Camera: NIDEK AFC-230; diabetic retinopathy graded by the modified Davis classification: 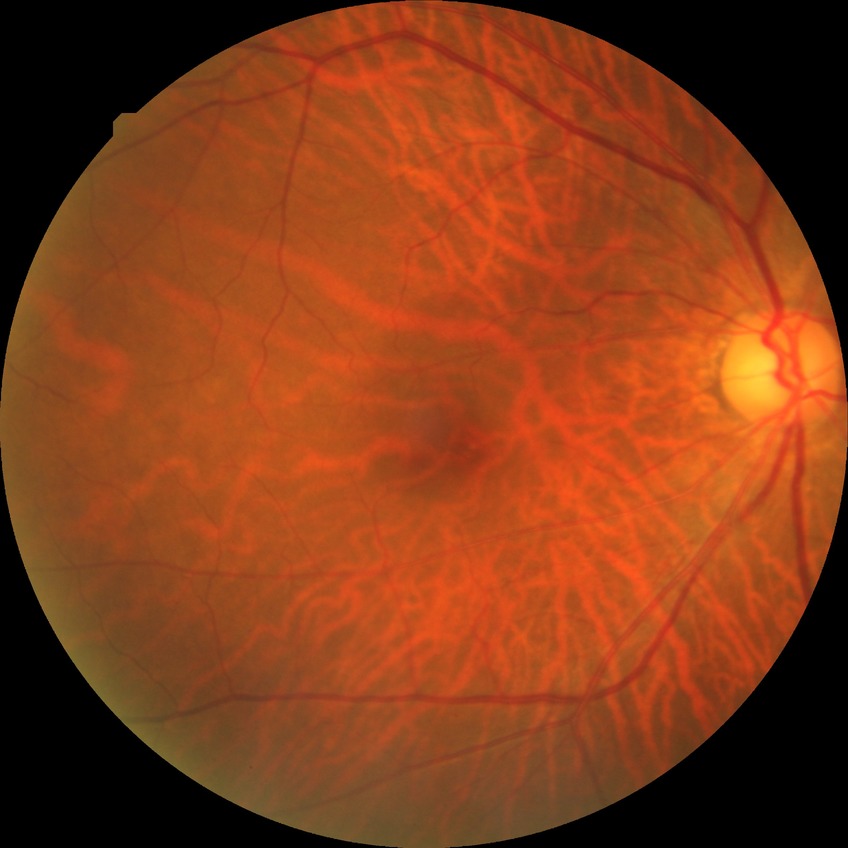
  davis_grade: NDR (no diabetic retinopathy)